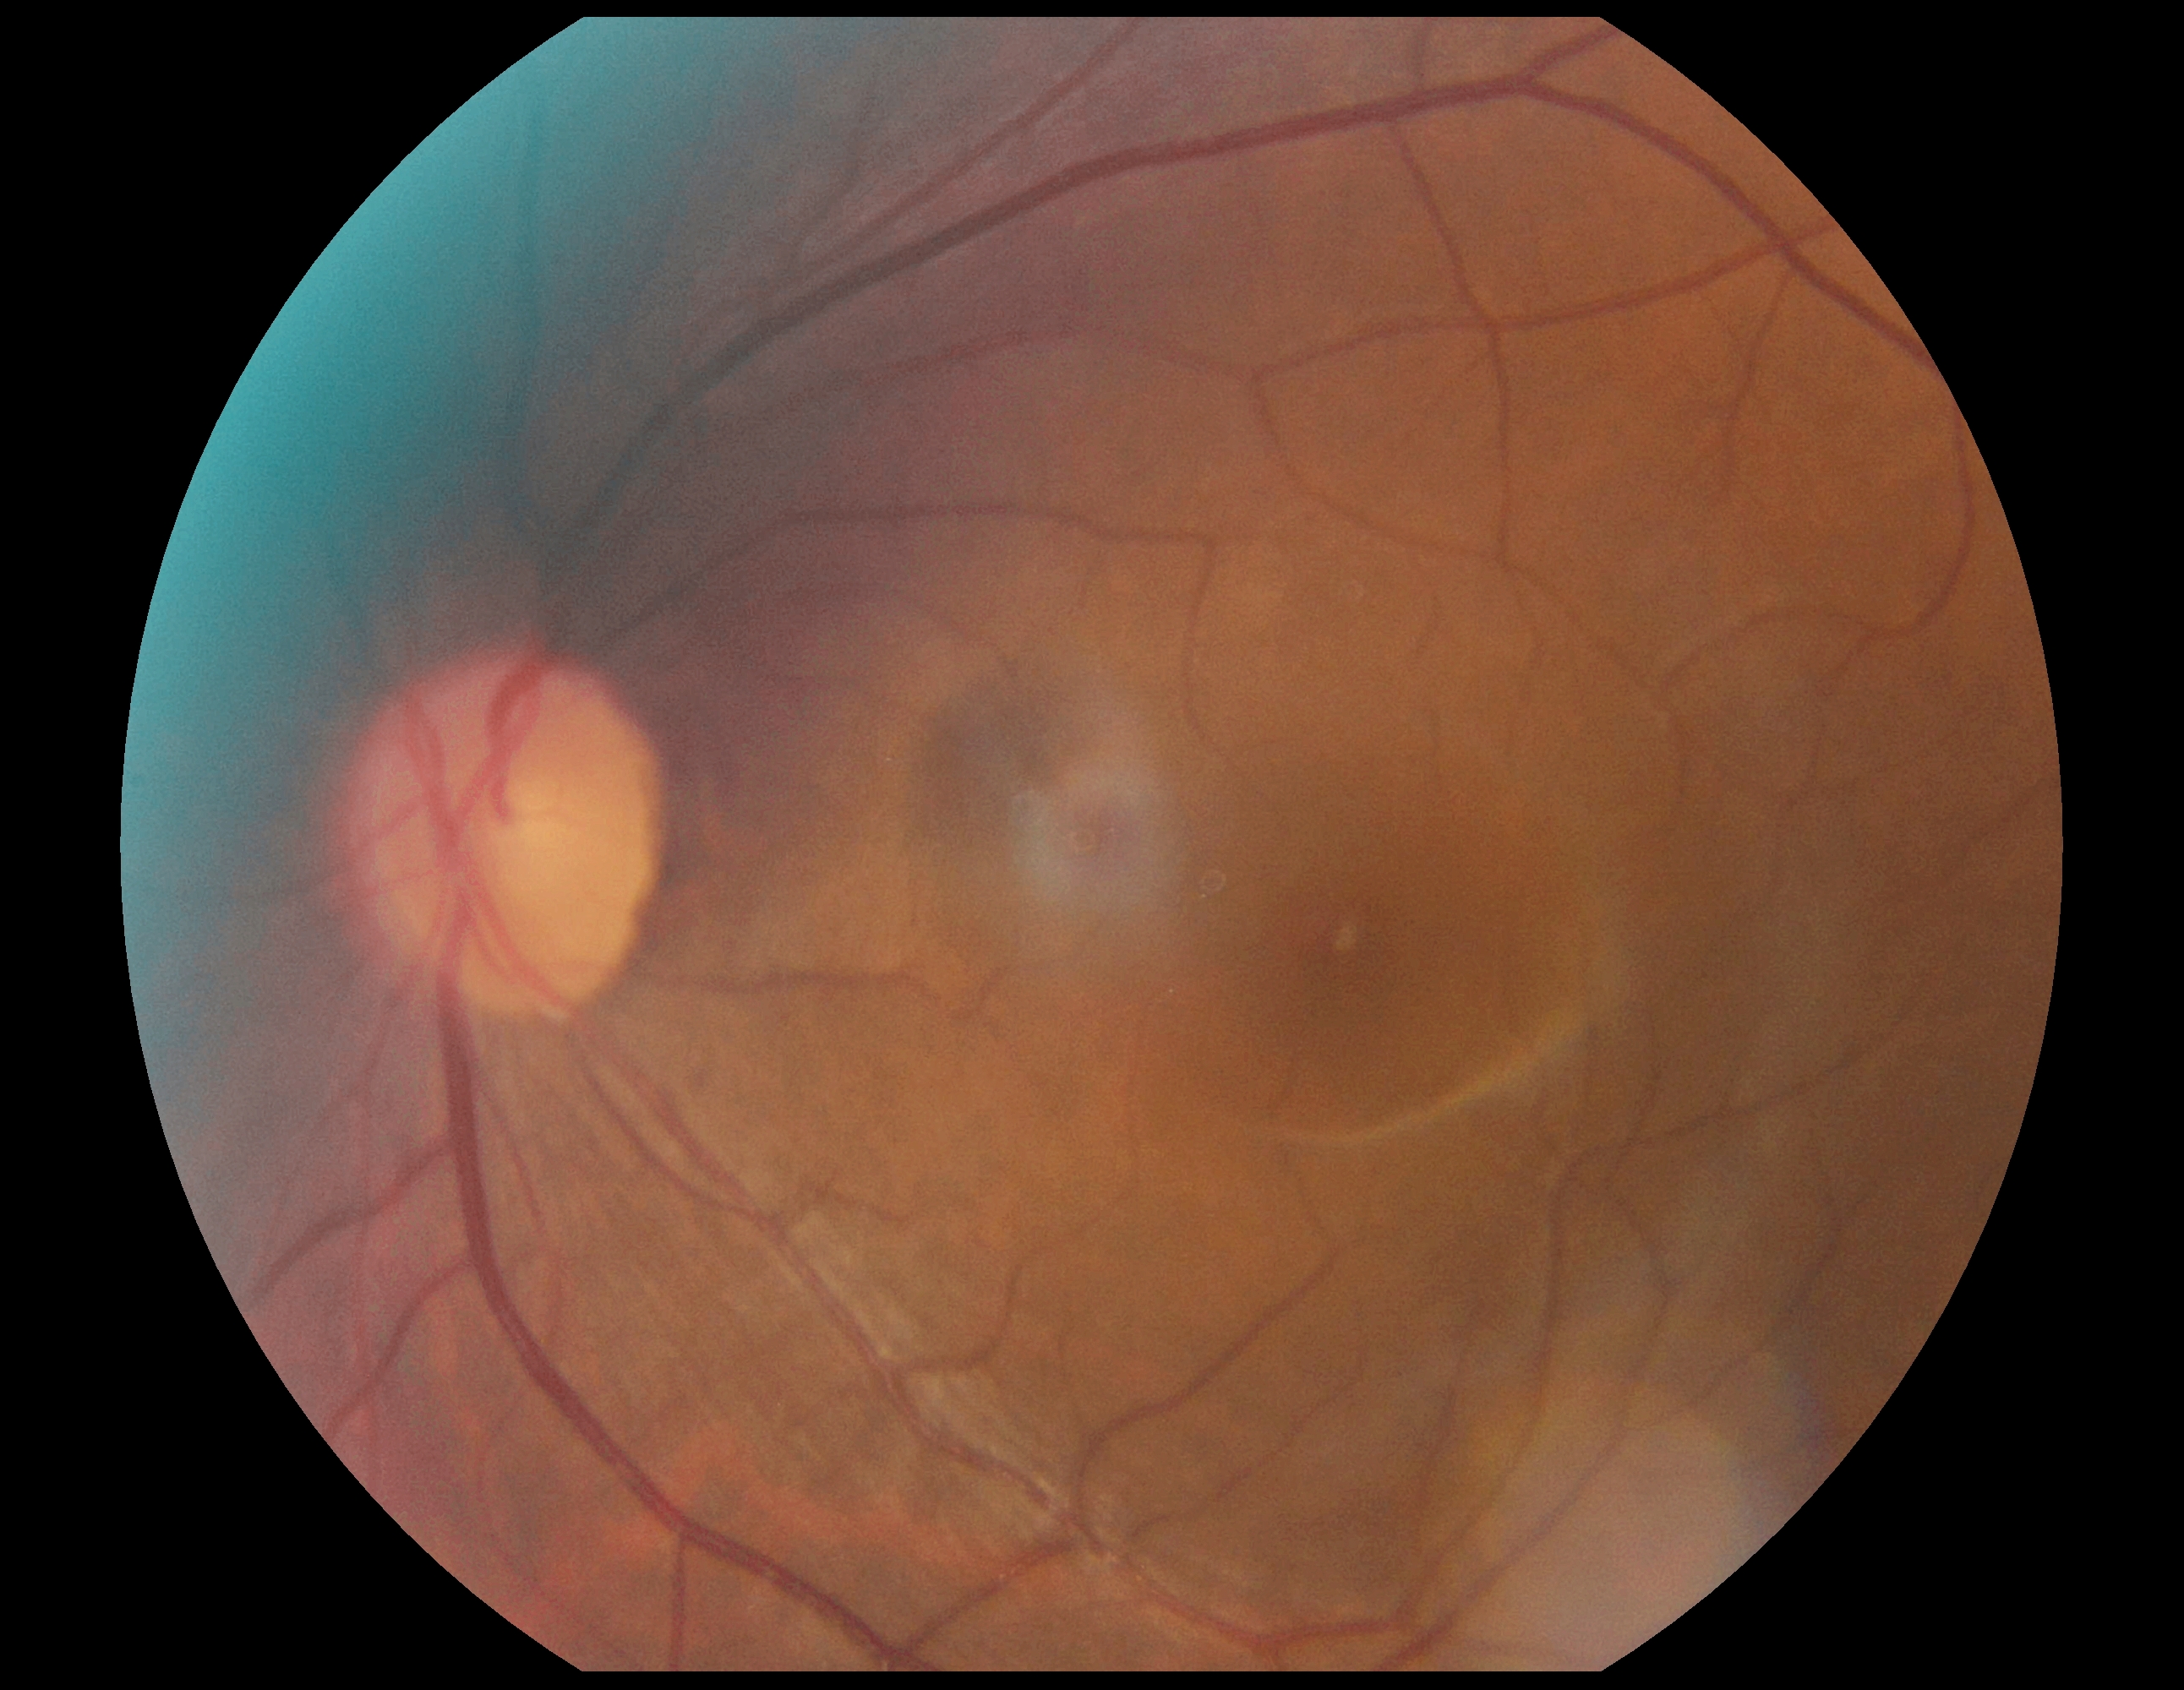
diabetic retinopathy (DR) = grade 0 | DR impression = no DR findings.